Color fundus photograph, 50° FOV: 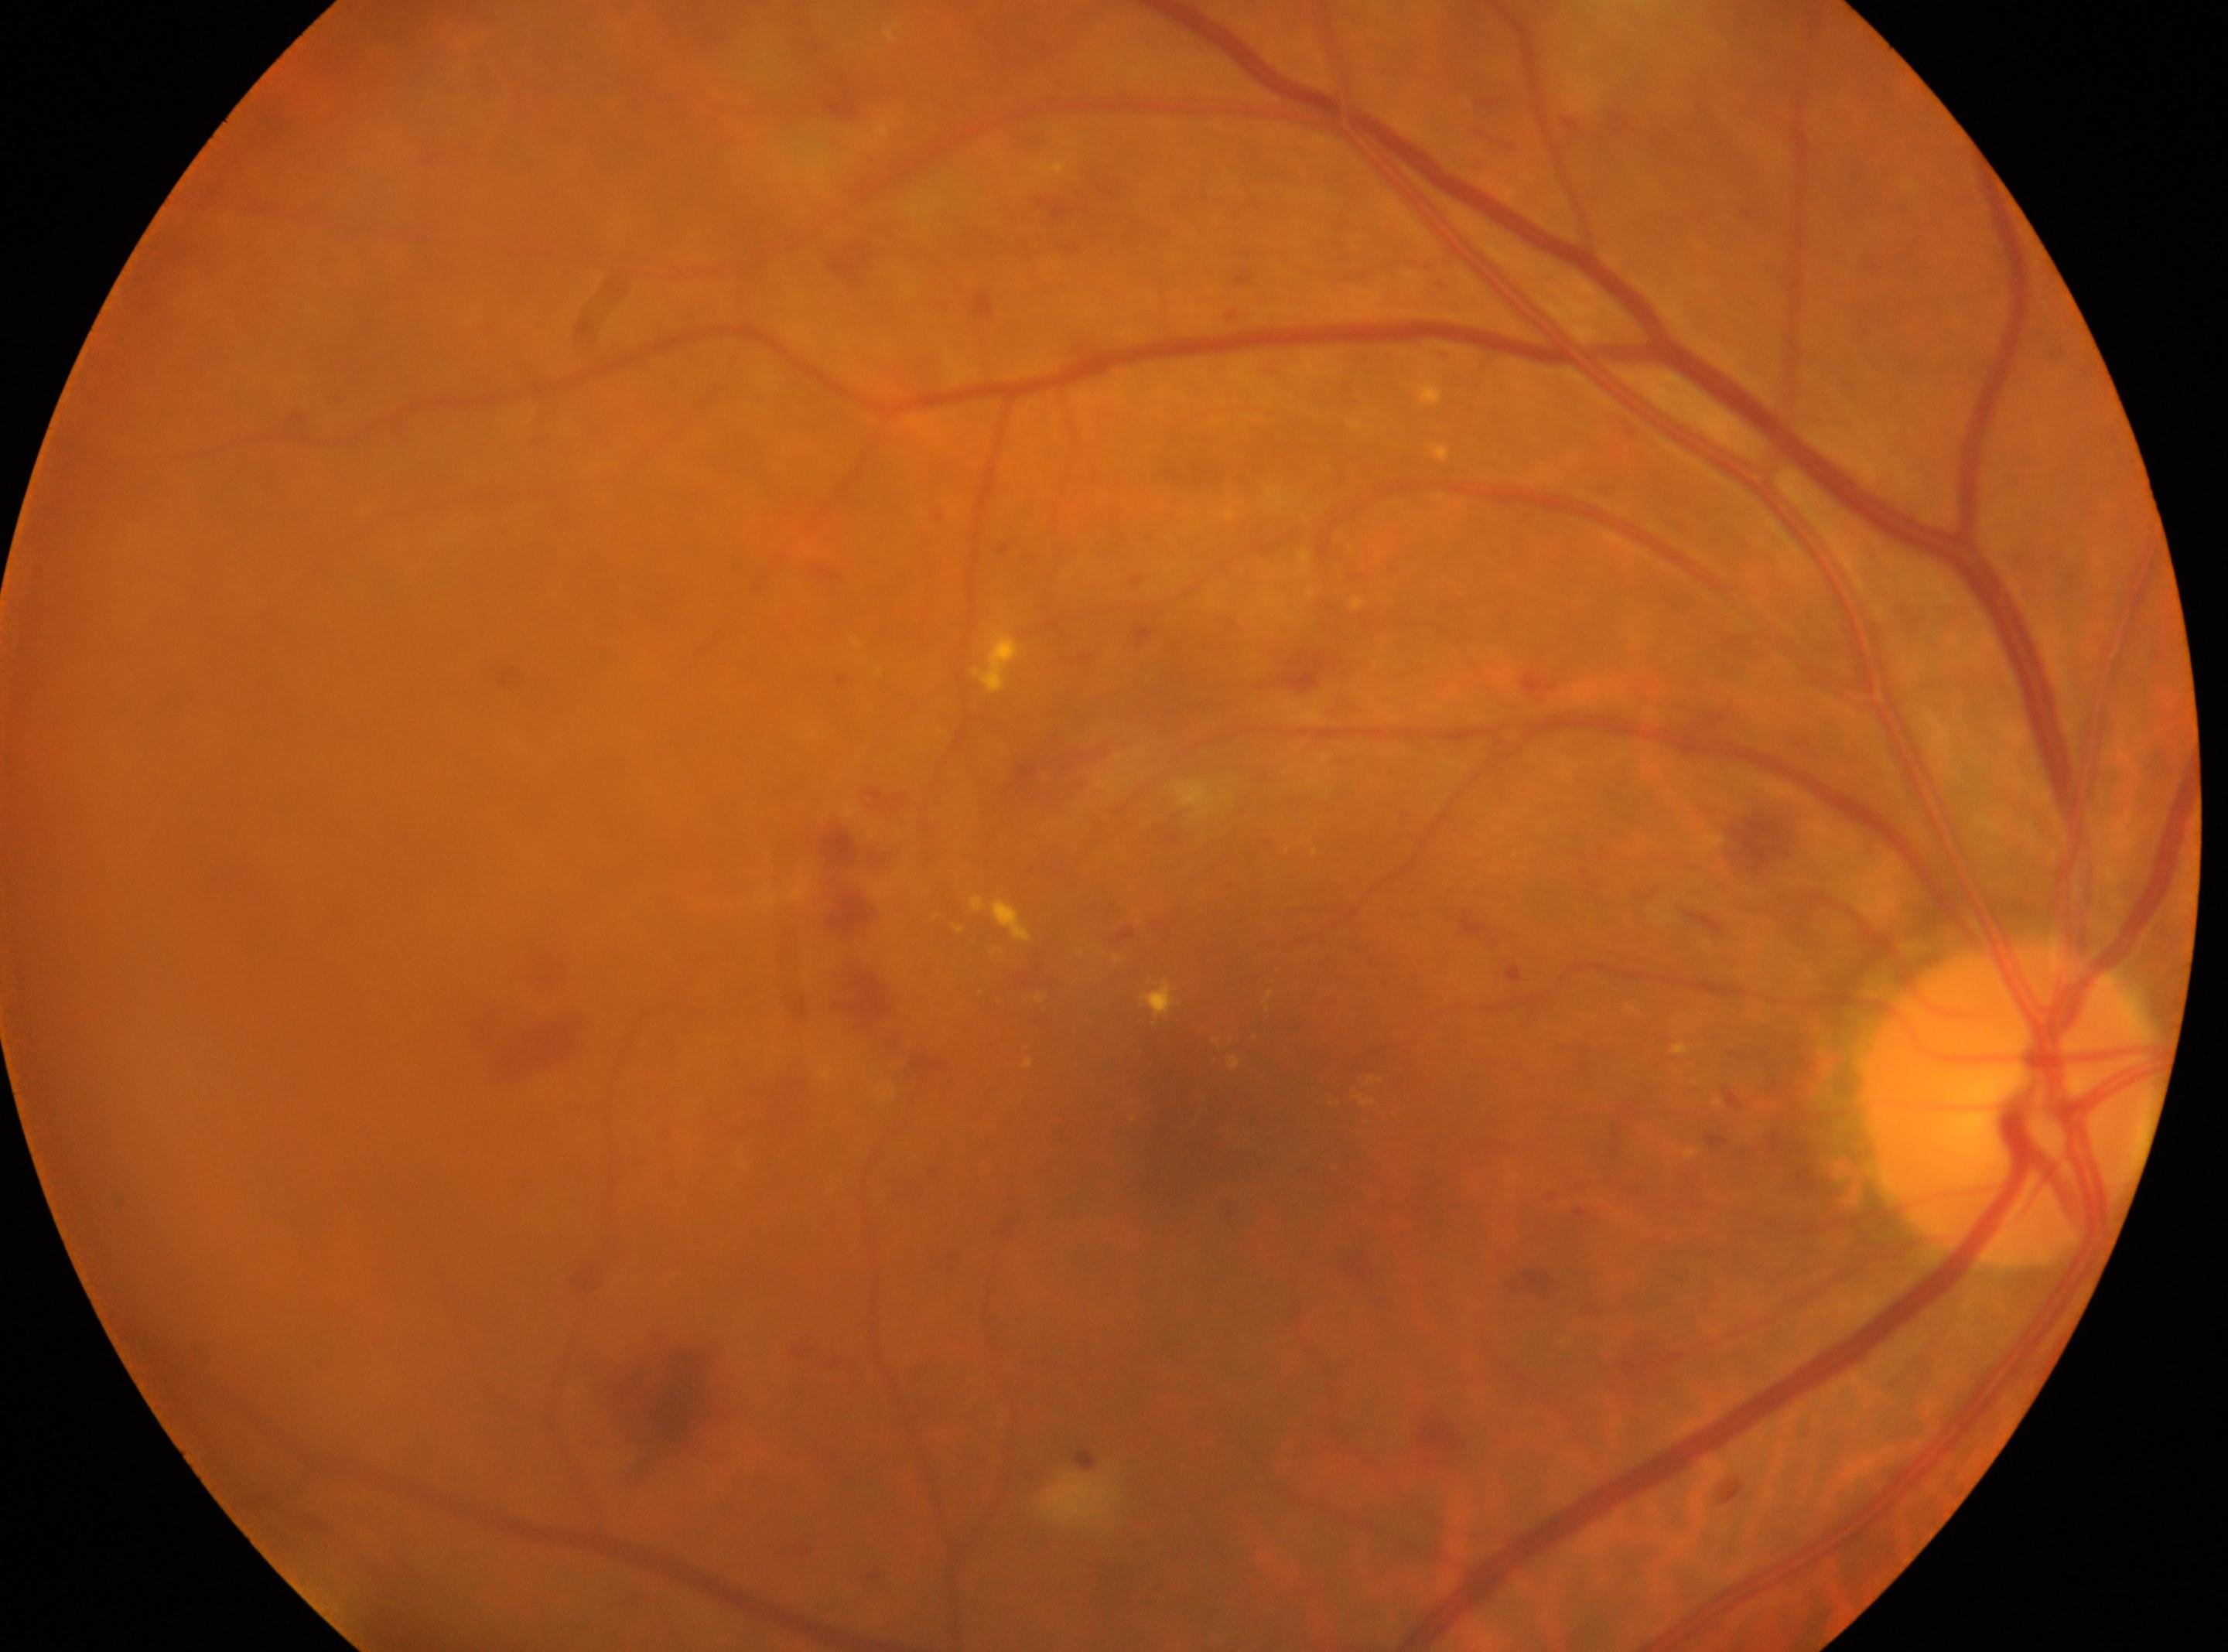
non-proliferative diabetic retinopathy
fovea centralis=(x=1194, y=1111)
DR severity=2
the optic disc=(x=2011, y=1104)
right eye